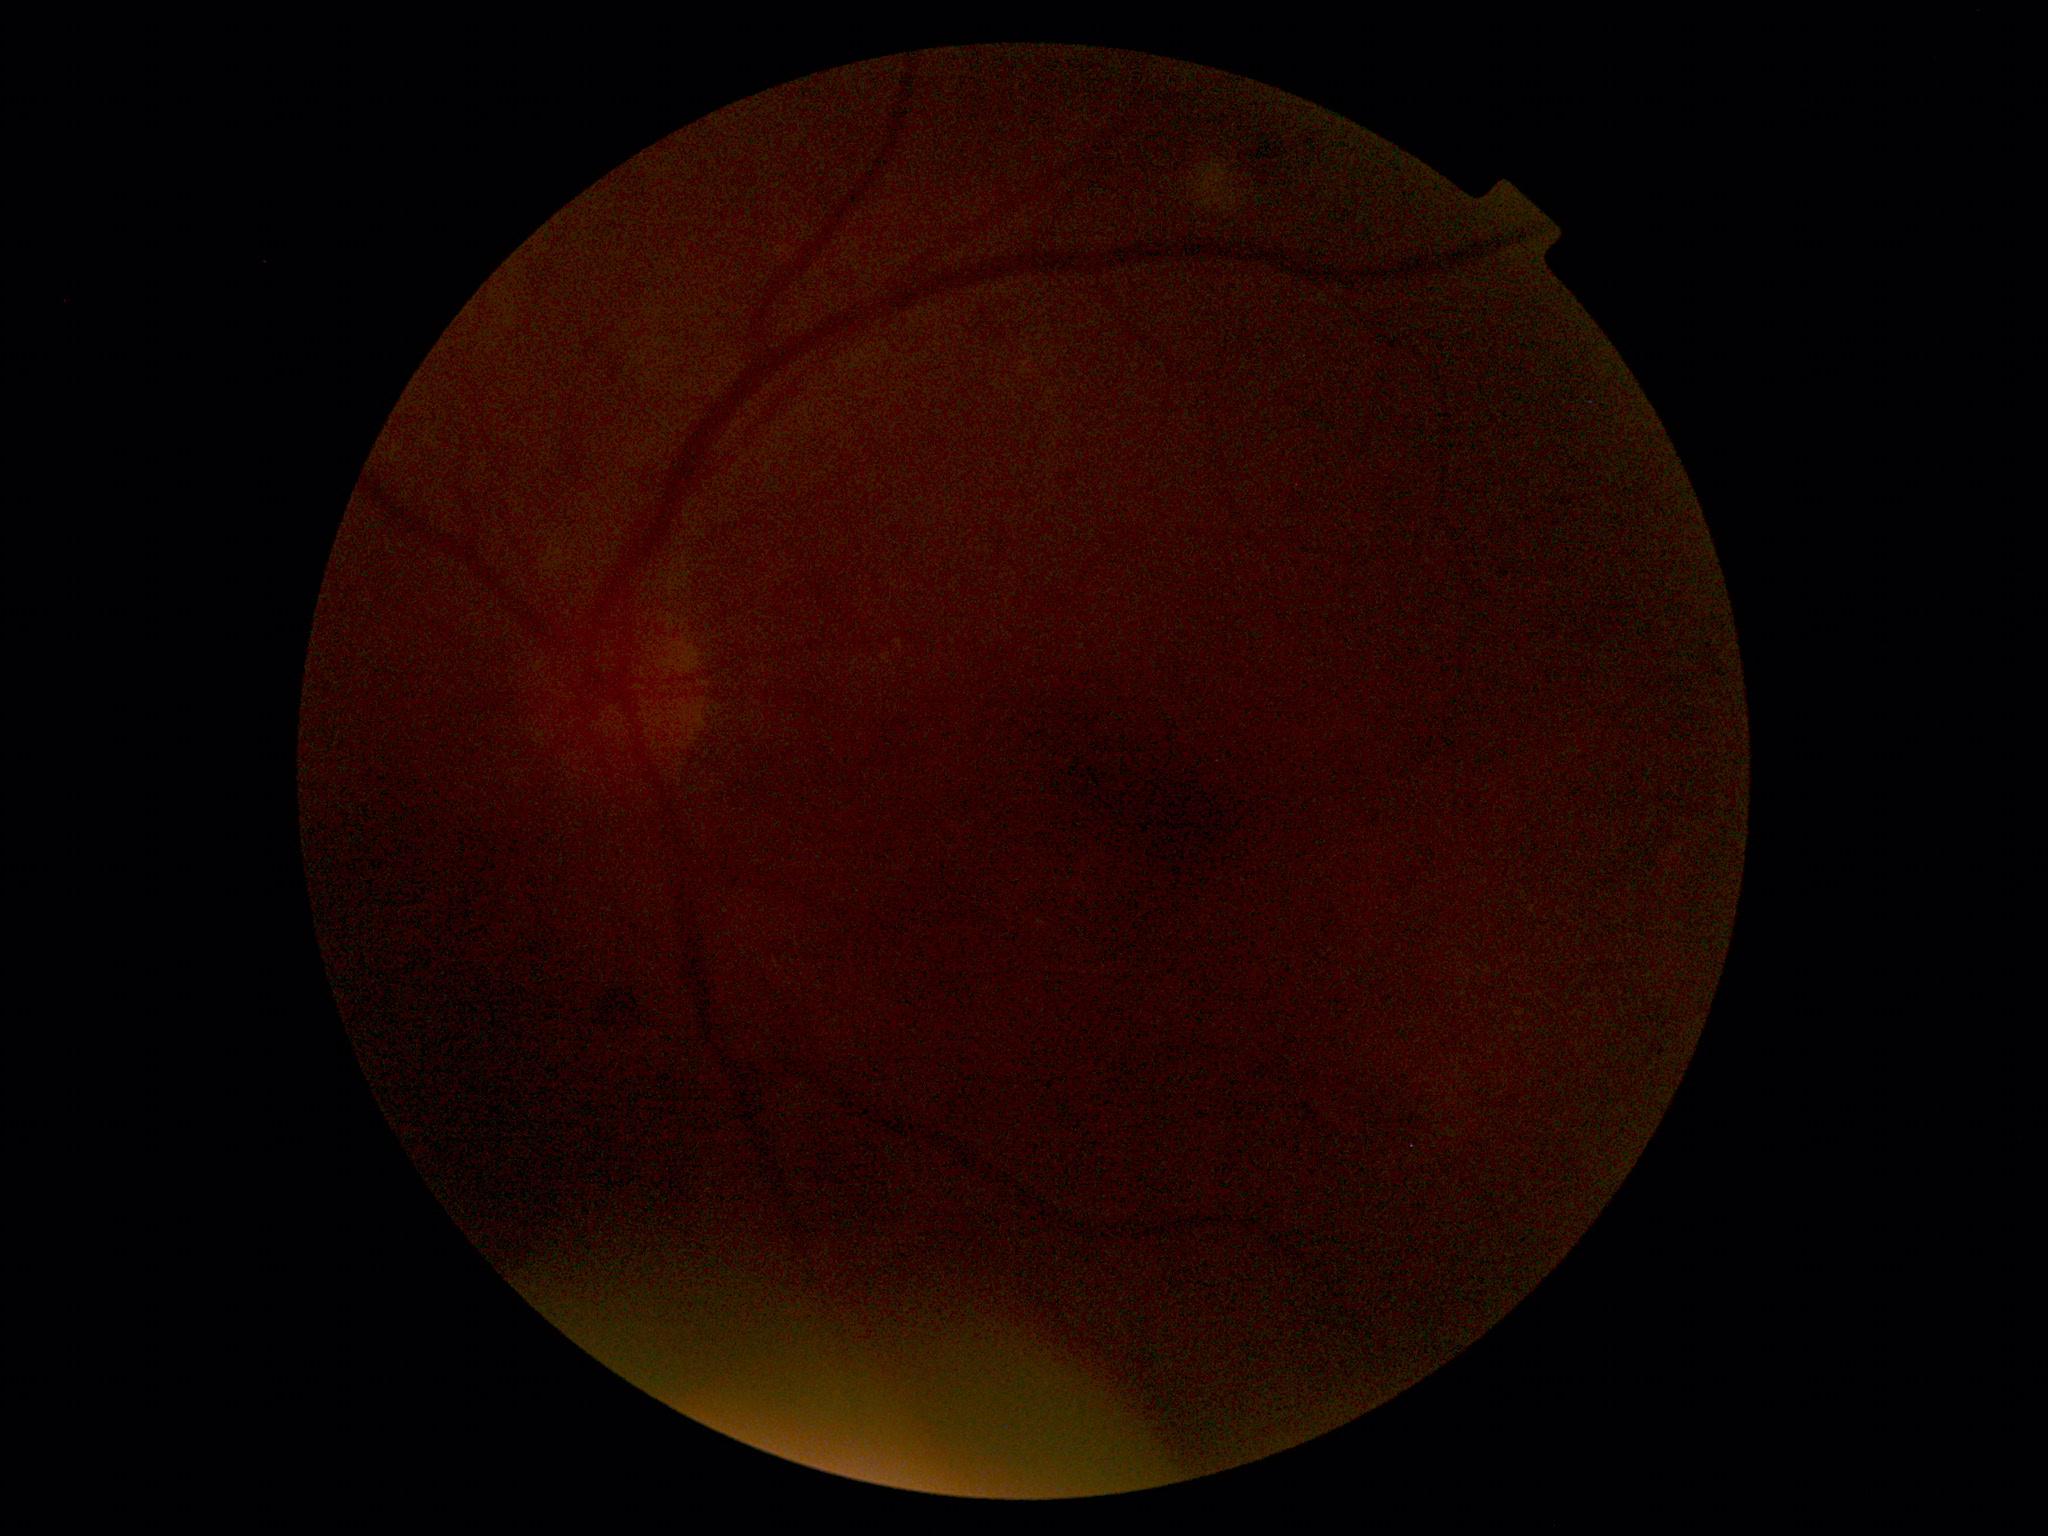
image quality: insufficient | DR severity: ungradable due to poor image quality.